Wide-field contact fundus photograph of an infant
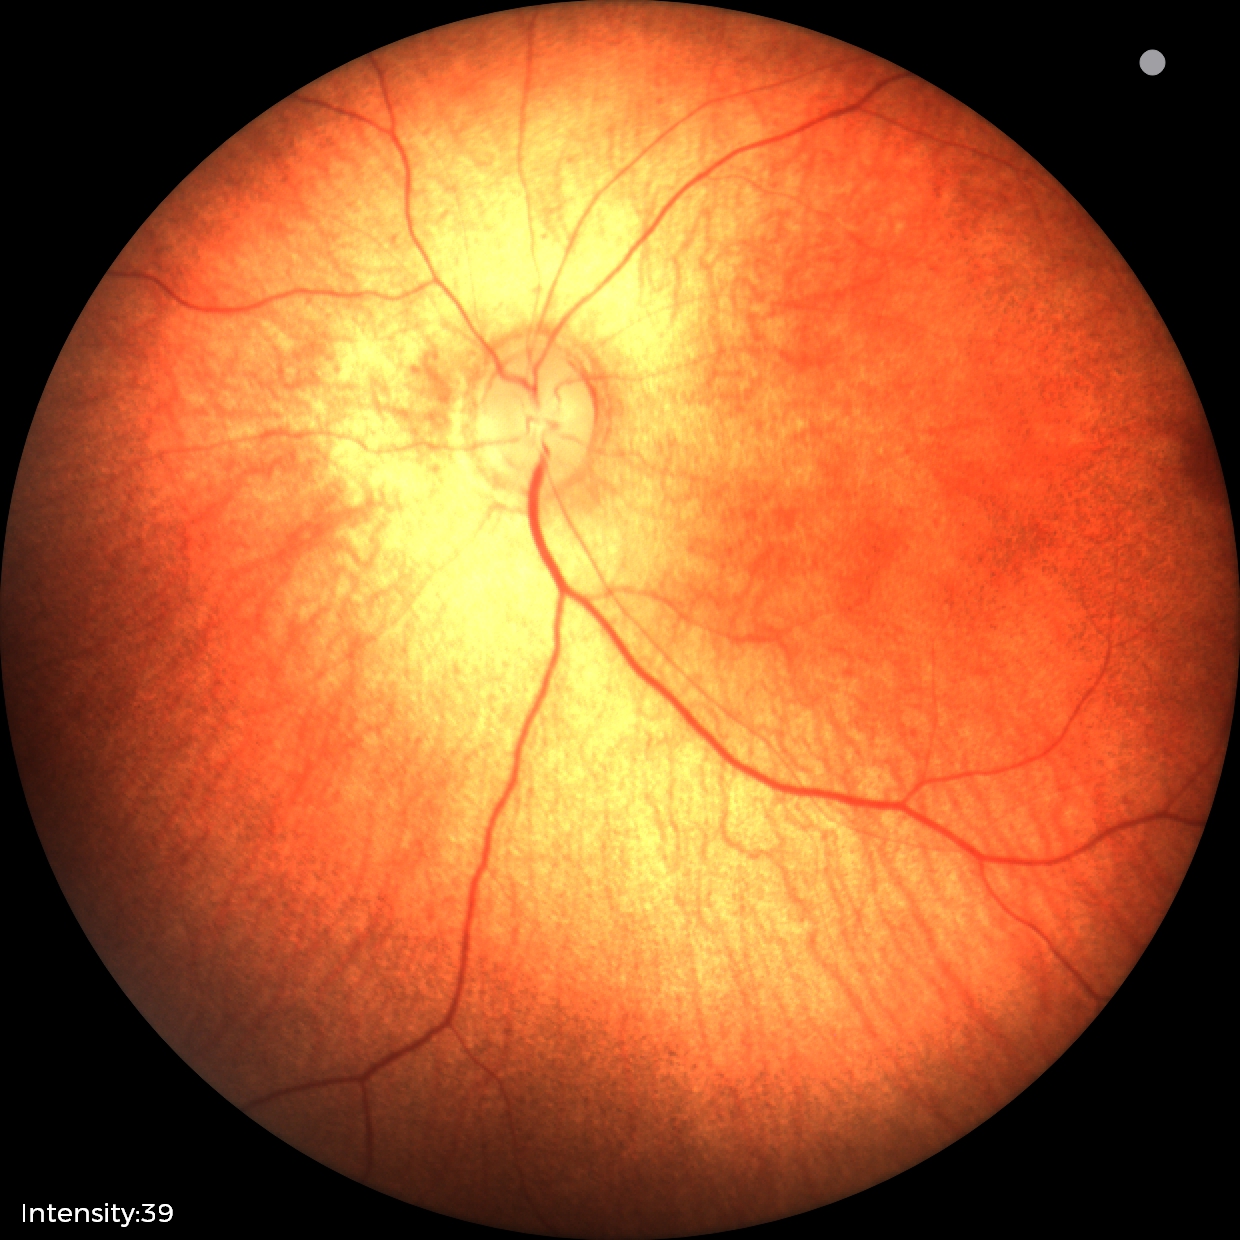

Screening examination with no abnormal retinal findings.